Graded on the modified Davis scale. Nonmydriatic fundus photograph.
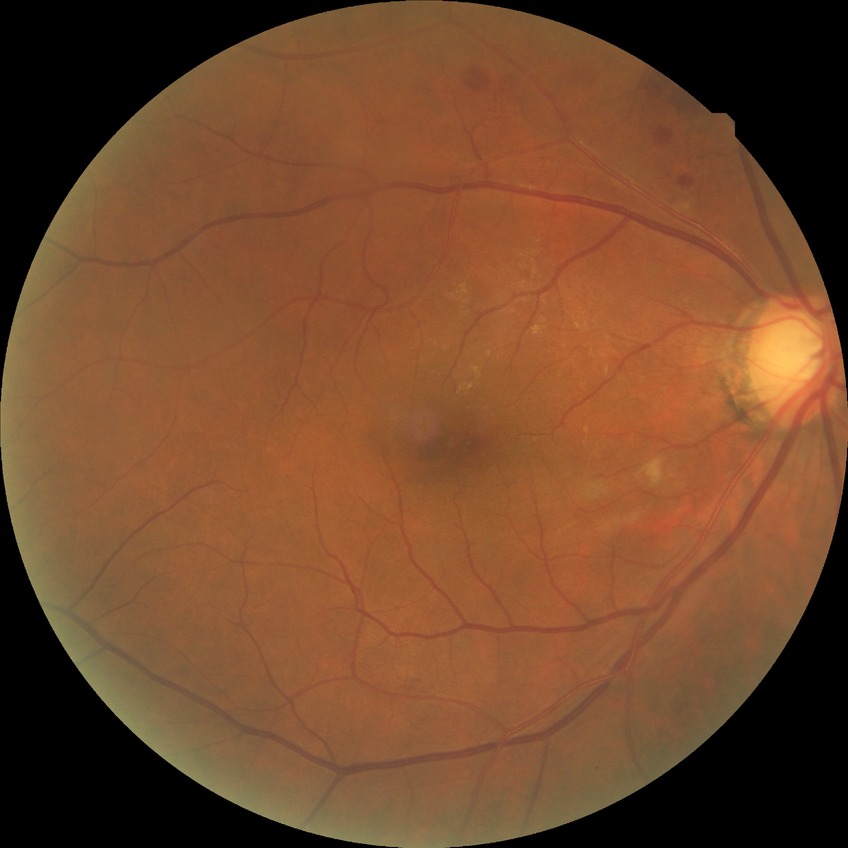

{
  "davis_grade": "pre-proliferative diabetic retinopathy"
}